Color fundus image: 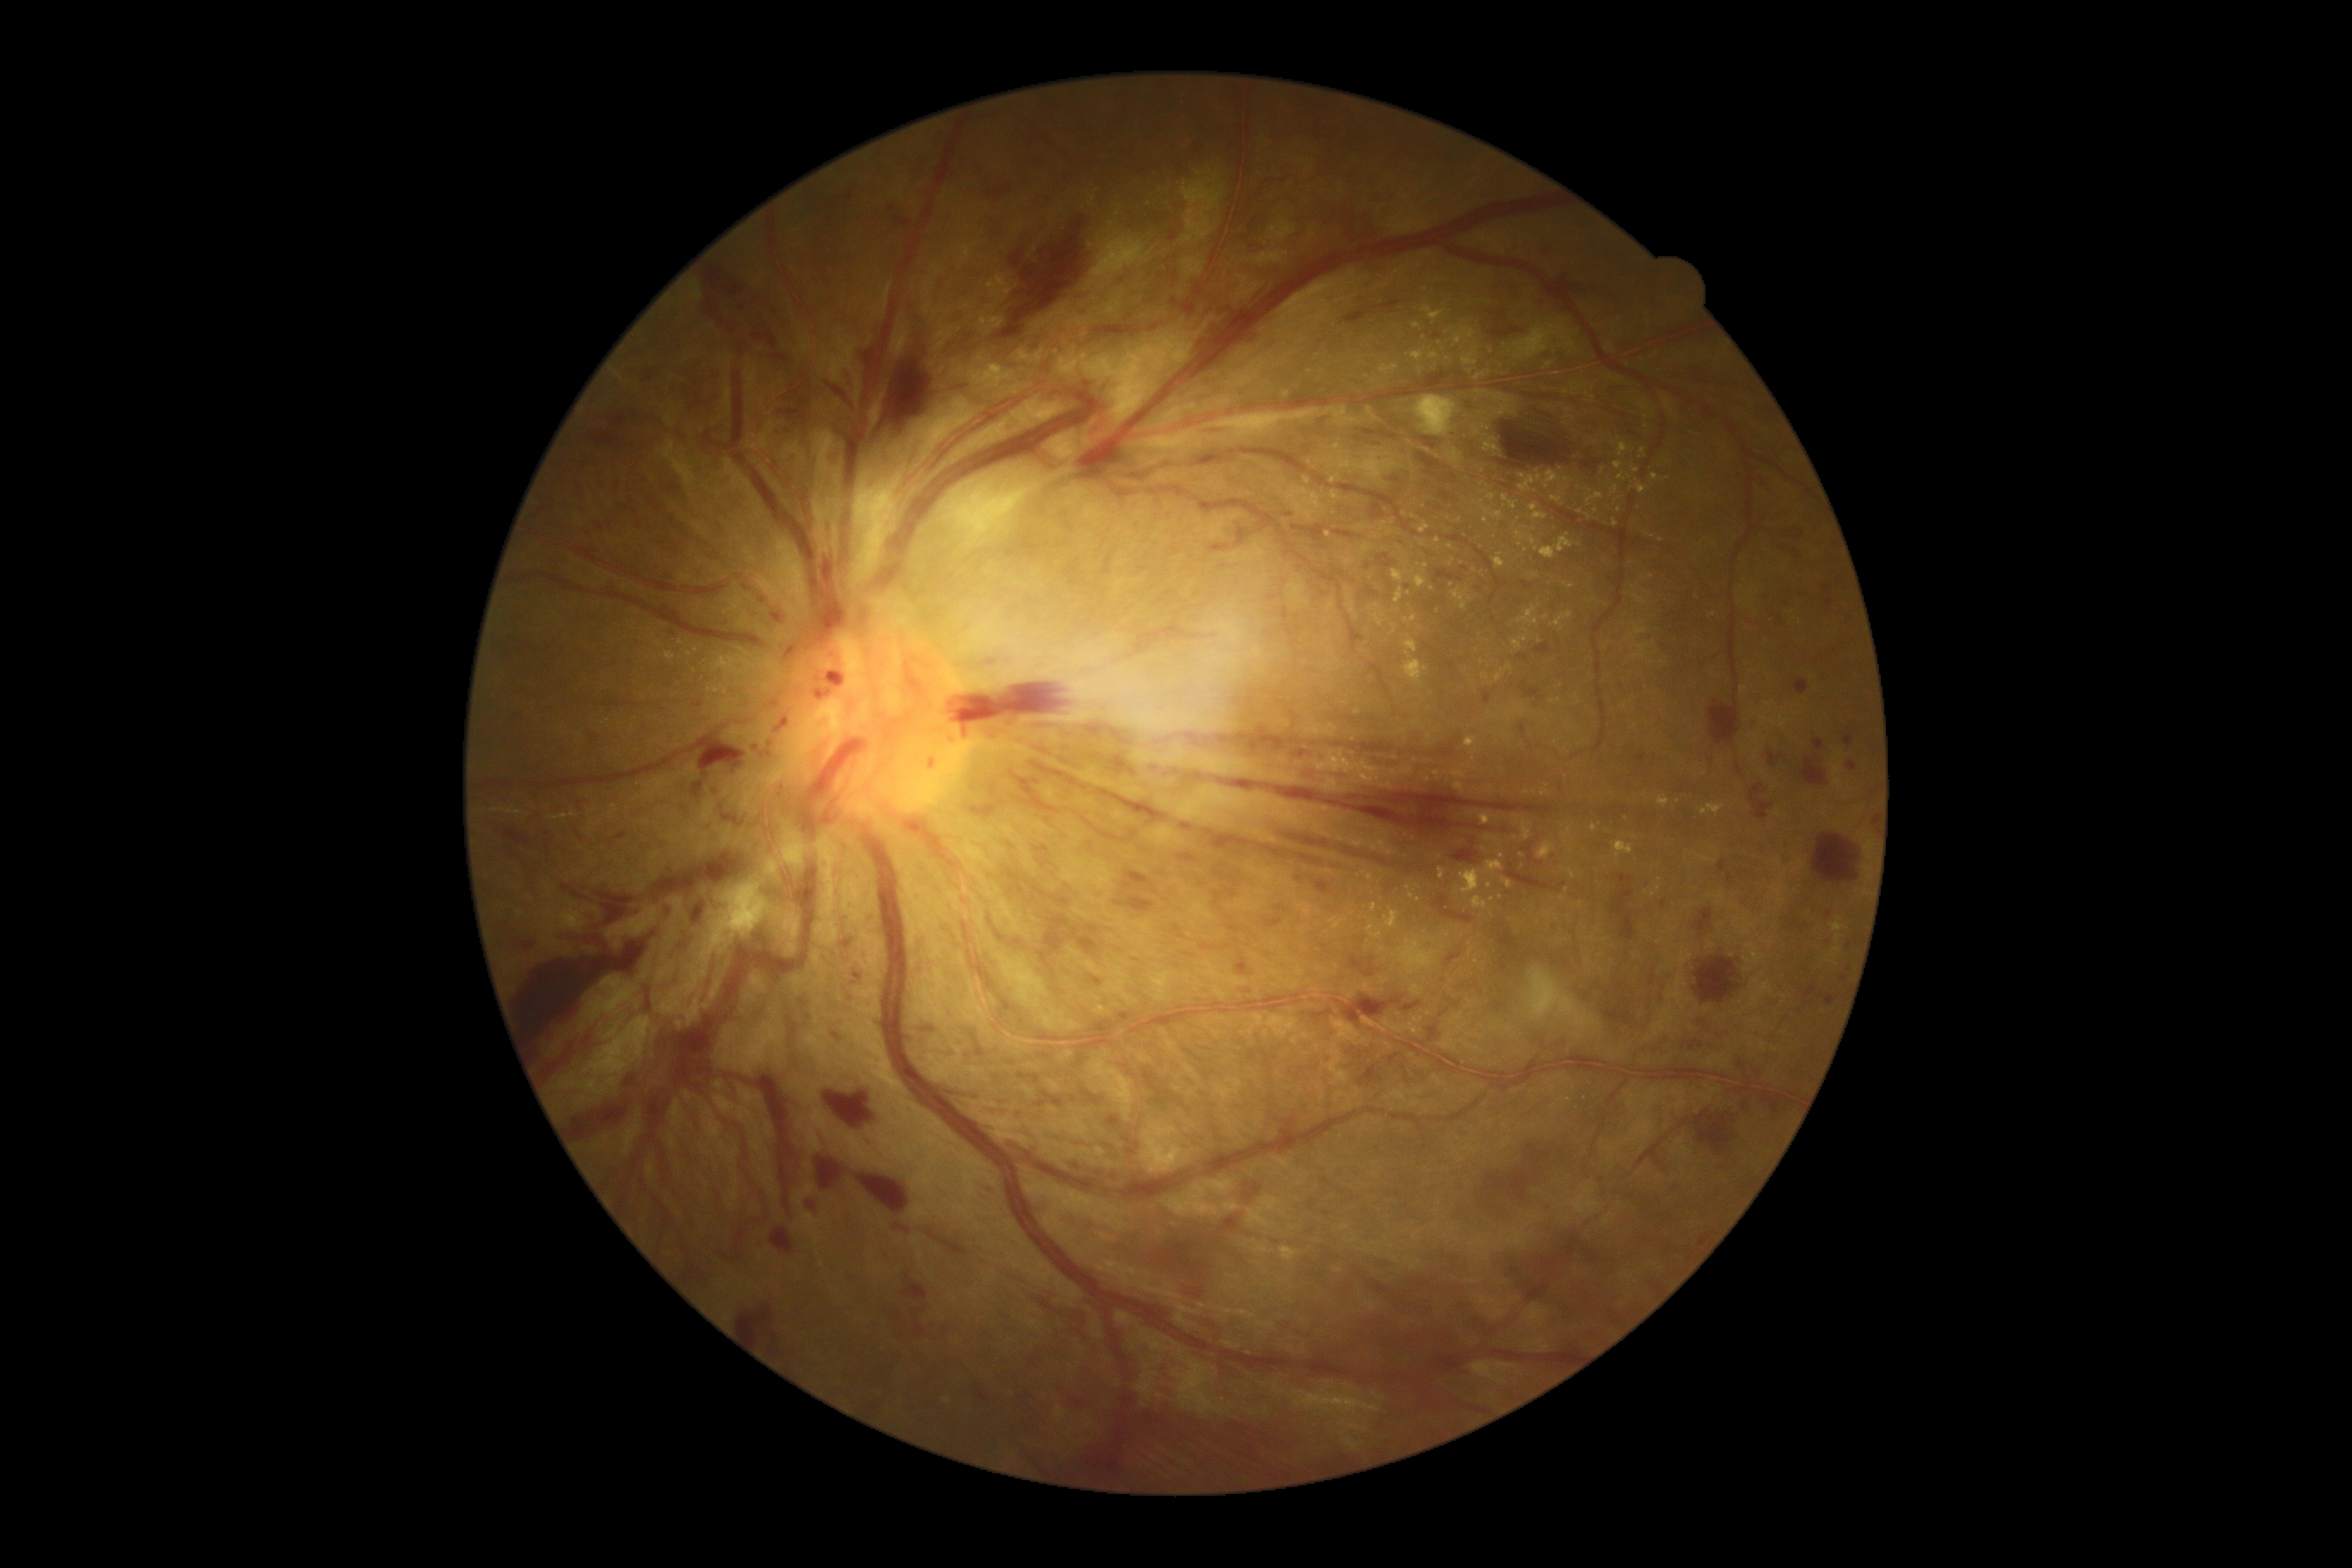
Diabetic retinopathy grade is 4 (PDR)
Lesions identified (partial list):
hard exudates (partial): x1=1366, y1=926, x2=1383, y2=938, x1=1550, y1=496, x2=1565, y2=506, x1=1651, y1=474, x2=1660, y2=481, x1=1416, y1=577, x2=1426, y2=589, x1=1392, y1=625, x2=1397, y2=634, x1=1381, y1=909, x2=1400, y2=929, x1=1316, y1=761, x2=1325, y2=771, x1=1516, y1=532, x2=1576, y2=560, x1=1495, y1=673, x2=1504, y2=682, x1=1311, y1=494, x2=1318, y2=503, x1=1586, y1=493, x2=1605, y2=506
Additional small hard exudates near (1421,370), (1084,358), (1339,447), (1007,289), (1505,346), (1287,723), (1580,512), (1535,575), (697,650)
hemorrhages (partial): x1=917, y1=1024, x2=938, y2=1032, x1=1058, y1=1211, x2=1106, y2=1227, x1=515, y1=914, x2=658, y2=1057, x1=1605, y1=1010, x2=1631, y2=1024, x1=754, y1=1075, x2=795, y2=1210, x1=665, y1=573, x2=678, y2=580, x1=763, y1=1242, x2=766, y2=1253, x1=1344, y1=310, x2=1369, y2=326, x1=940, y1=1087, x2=979, y2=1101, x1=640, y1=364, x2=658, y2=377, x1=1433, y1=897, x2=1474, y2=924, x1=1265, y1=919, x2=1283, y2=929, x1=1227, y1=890, x2=1239, y2=897, x1=1825, y1=910, x2=1832, y2=921, x1=1694, y1=1112, x2=1736, y2=1156, x1=1053, y1=1096, x2=1067, y2=1105, x1=623, y1=1072, x2=639, y2=1089, x1=769, y1=353, x2=790, y2=360
Additional small hemorrhages near (771,744), (779,793)